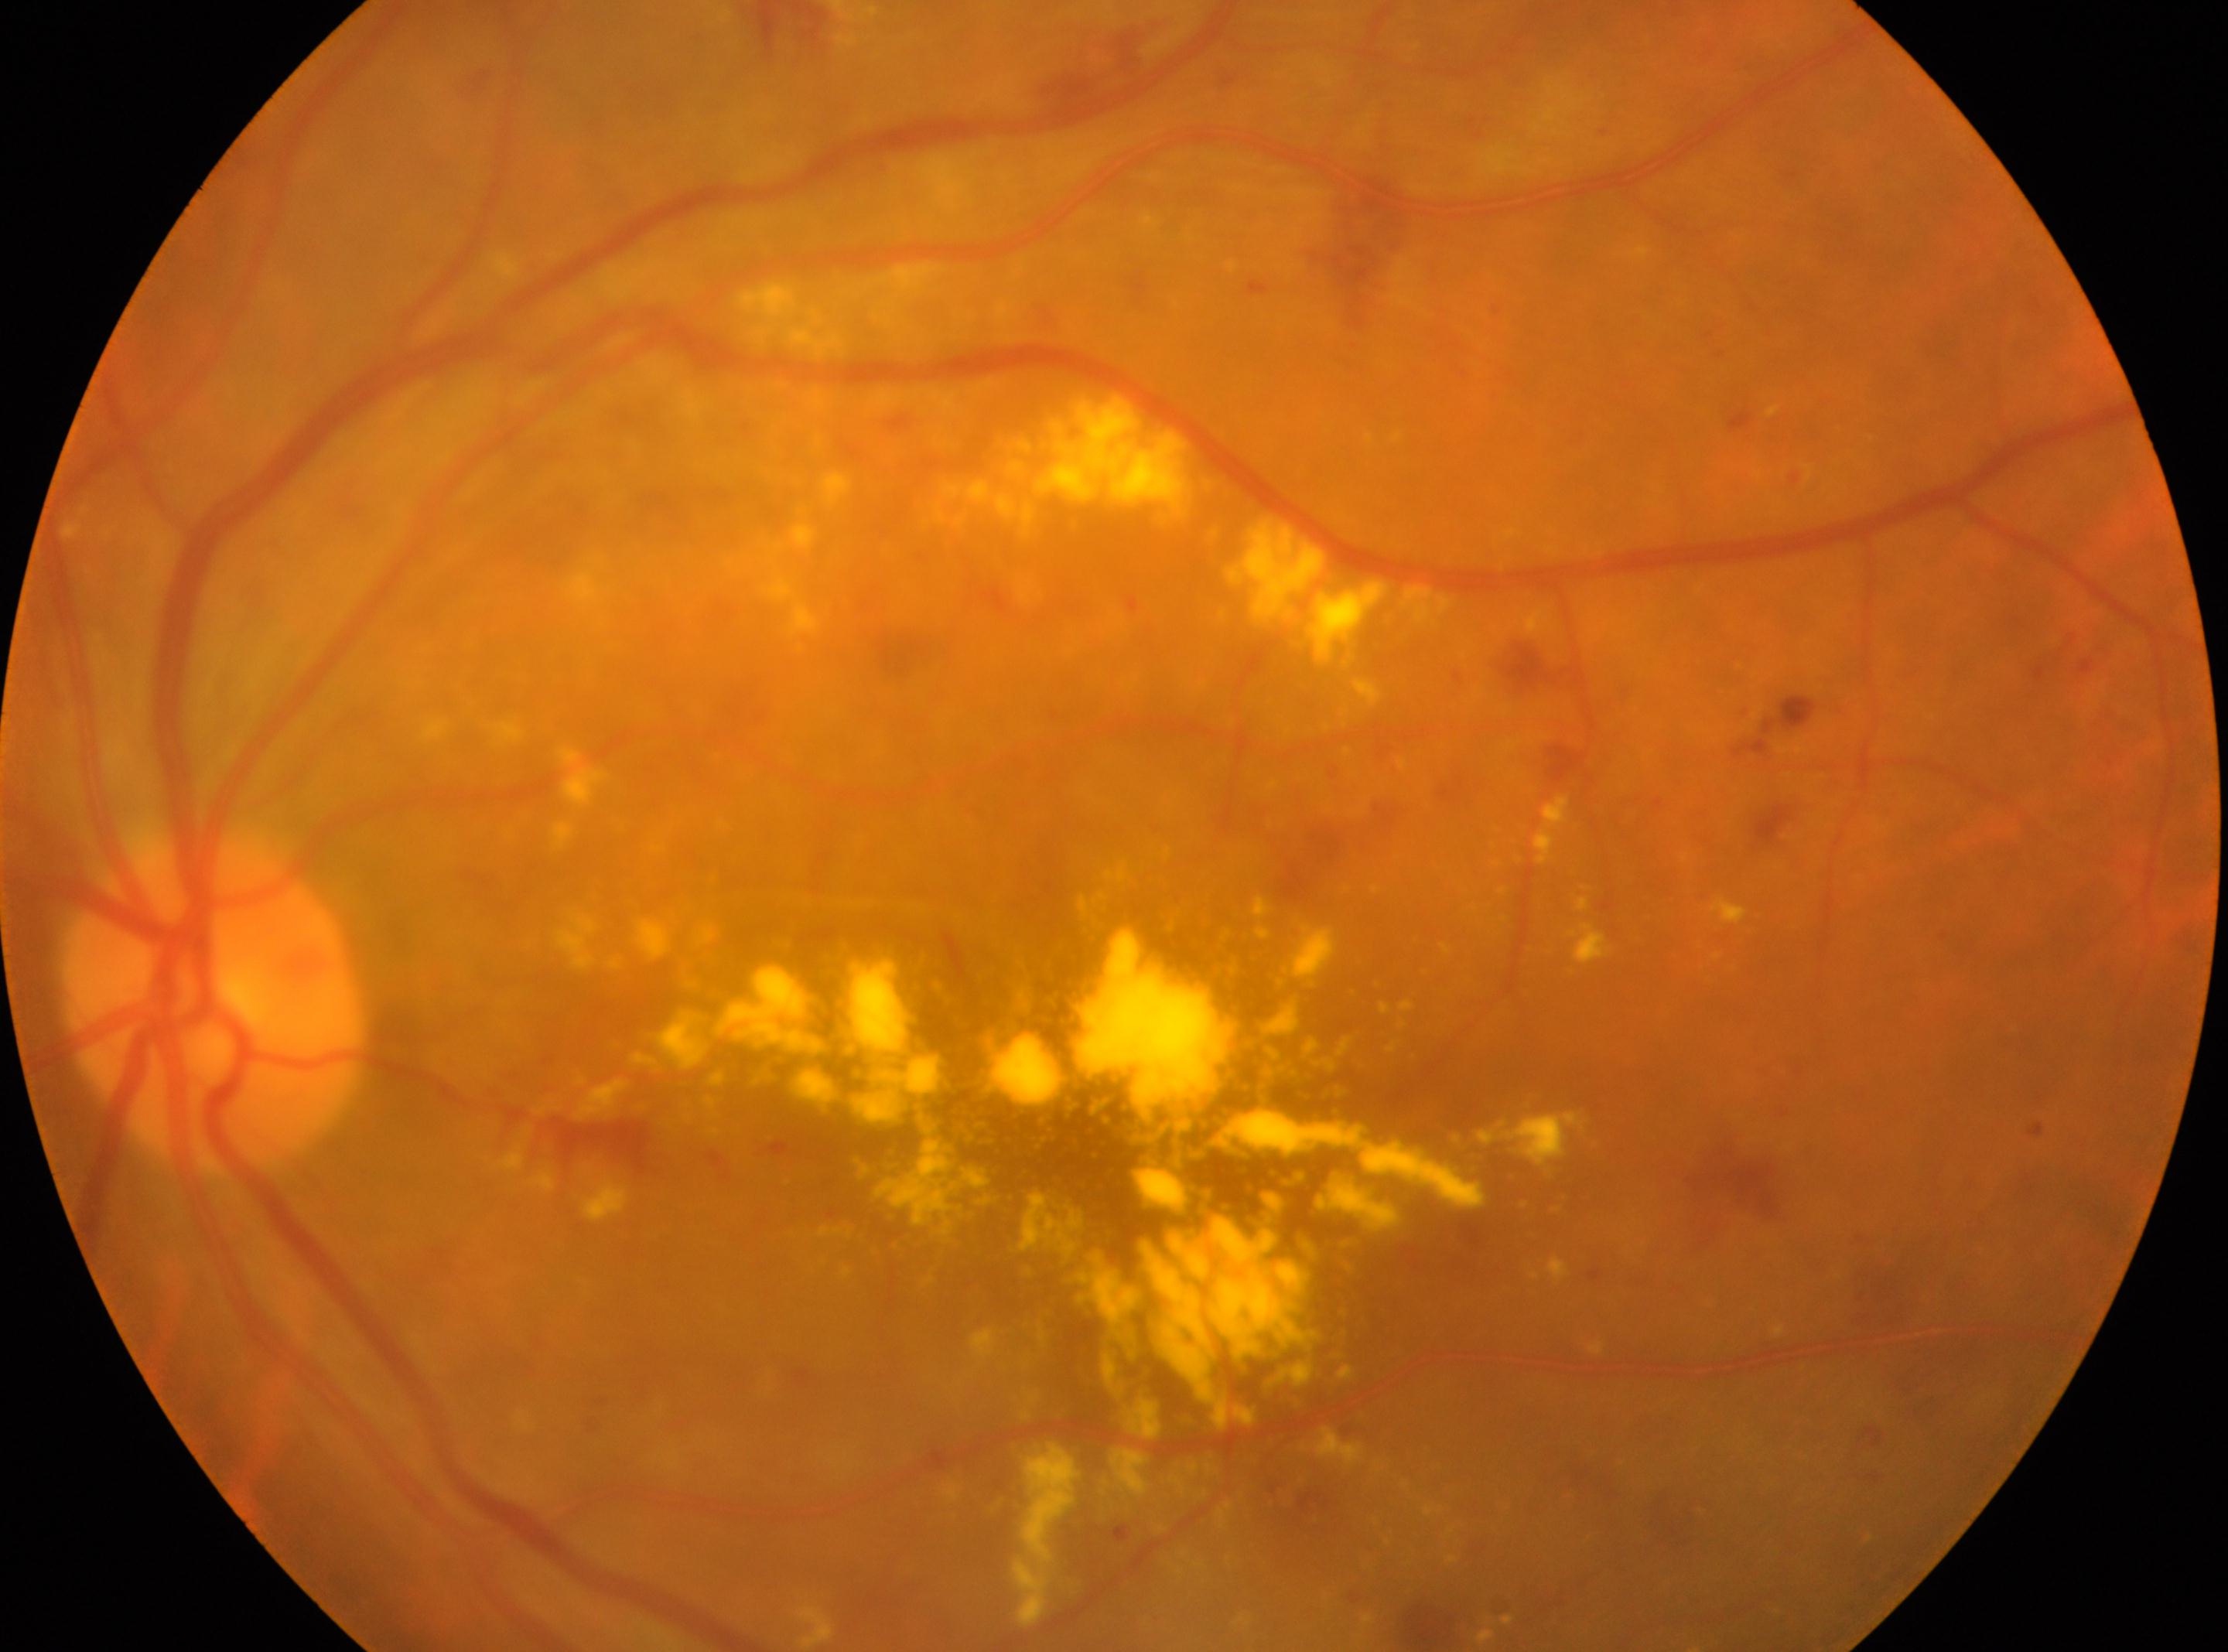
Macular center: (1092,1163).
Imaged eye: left.
ONH: (214,1007).
Diabetic retinopathy grade: 2 (moderate NPDR) — more than just microaneurysms but less than severe NPDR.